Fundus photo
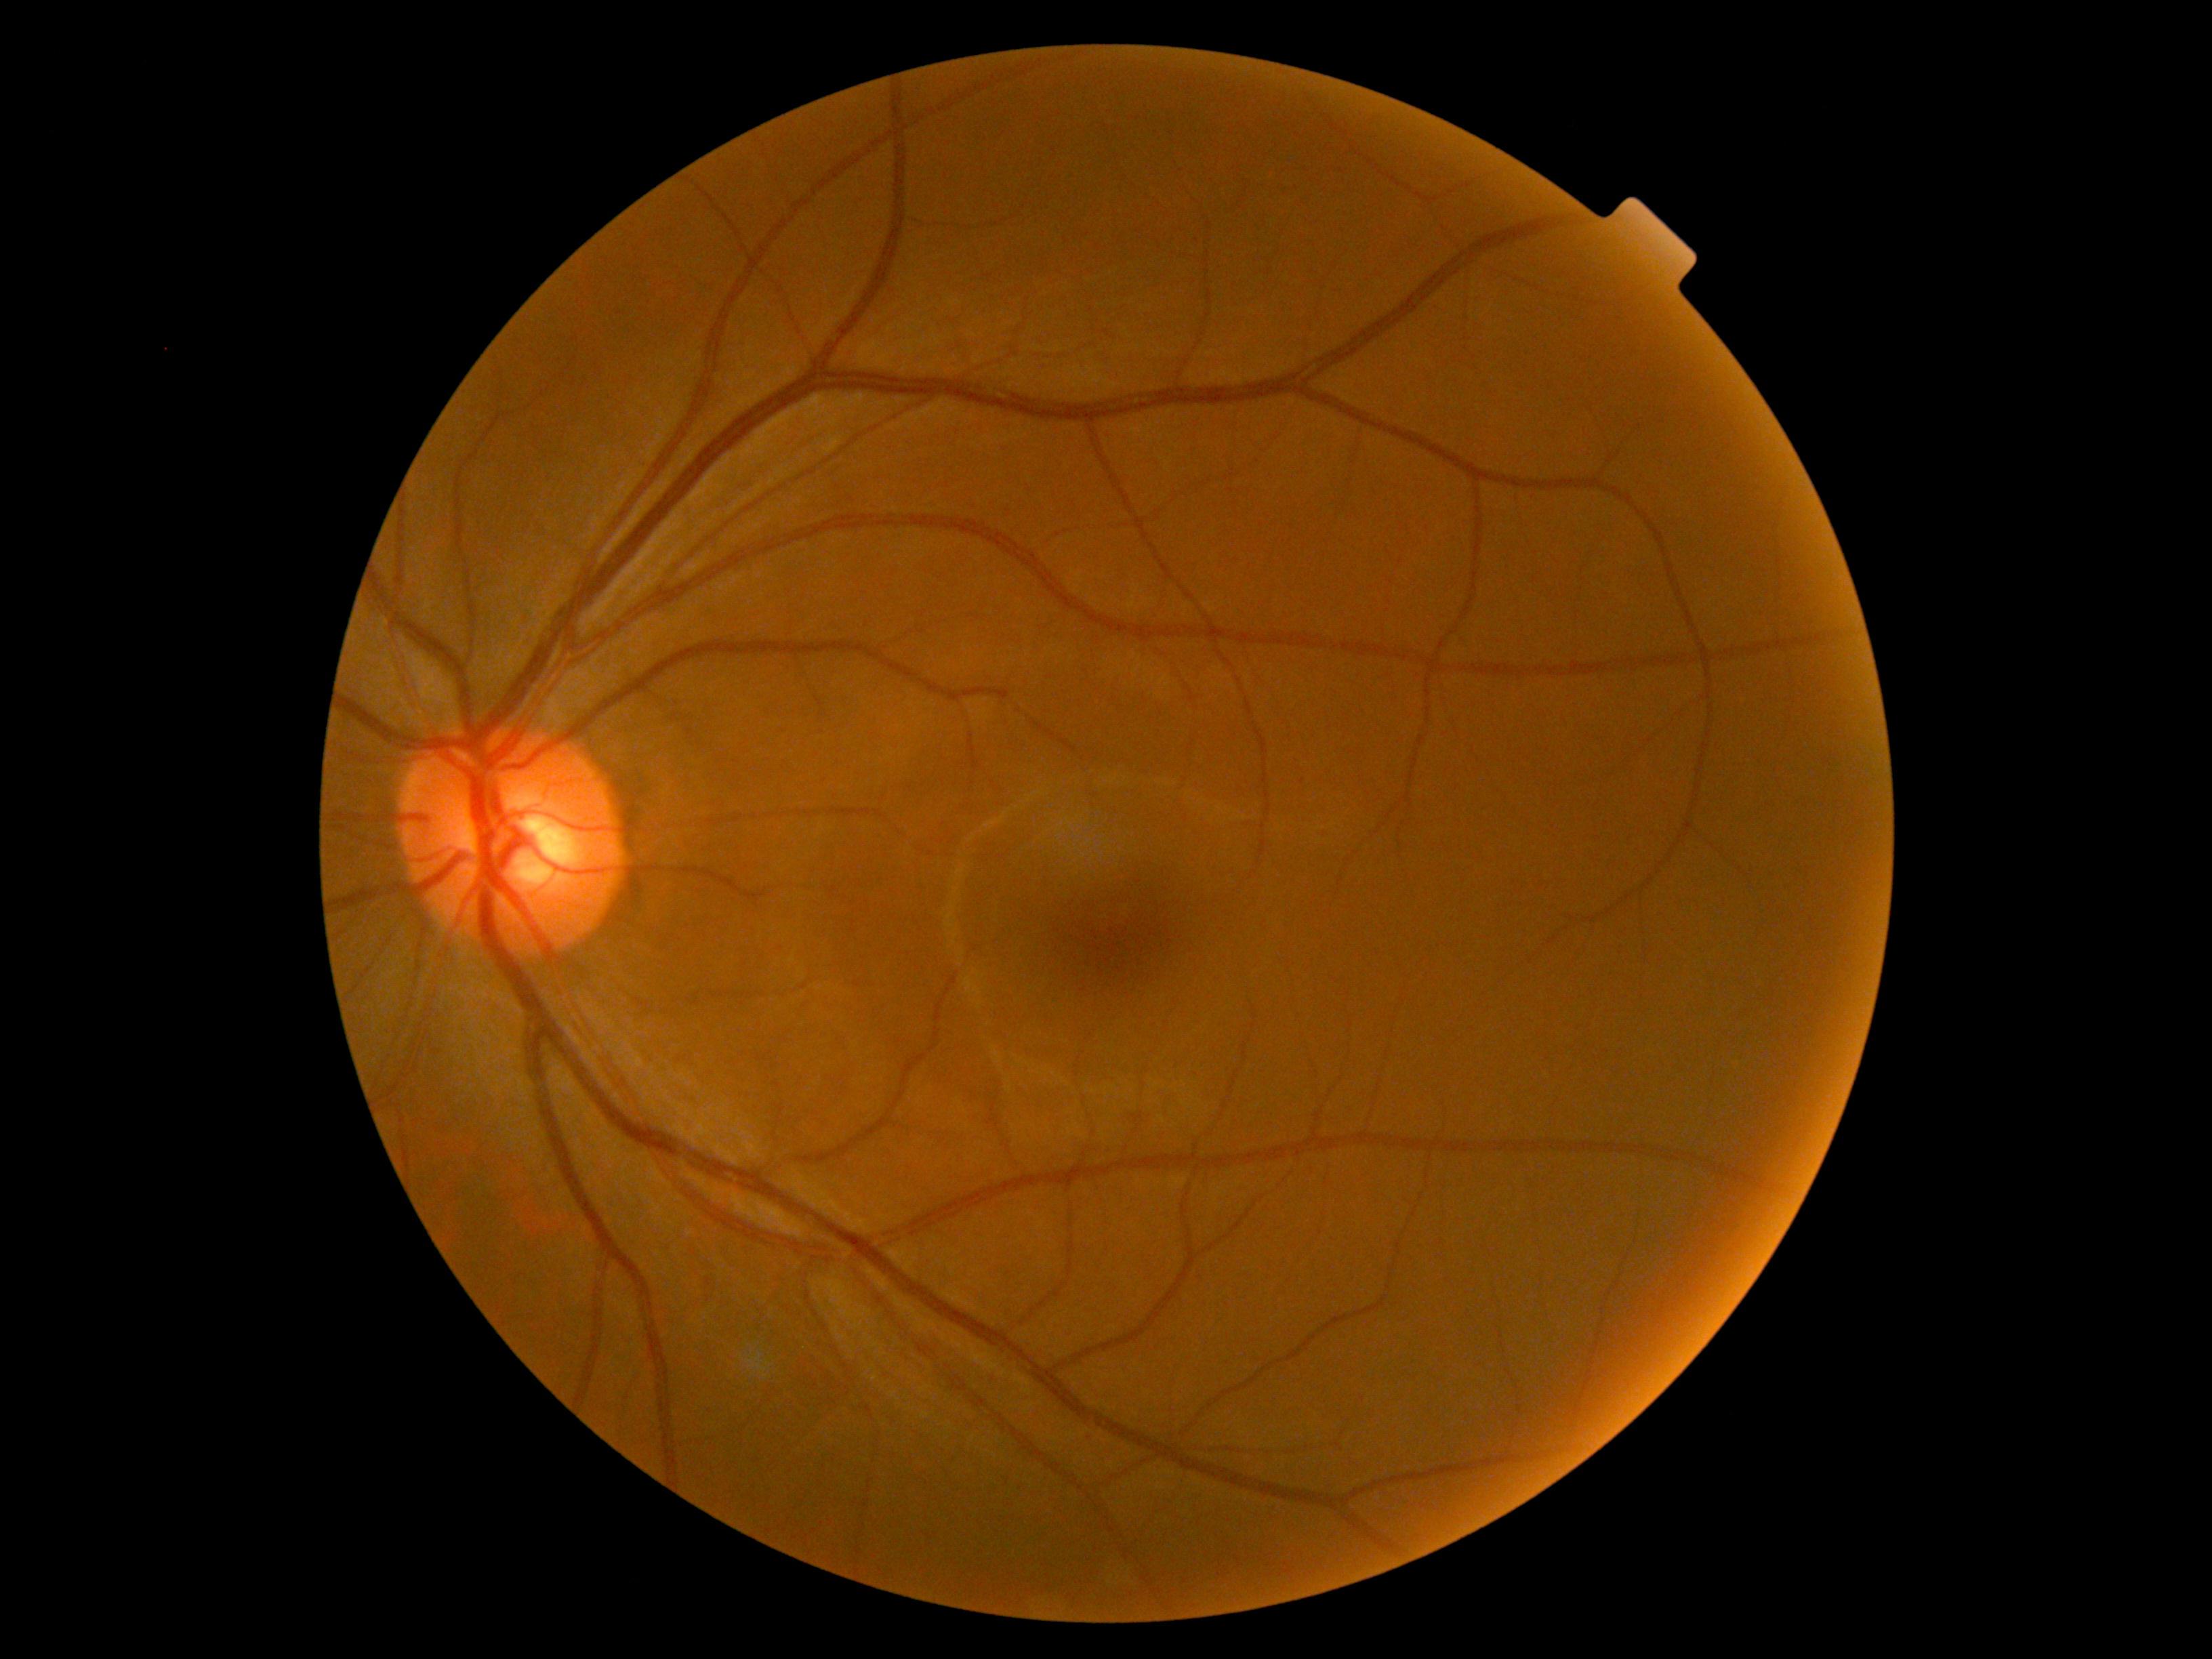

diabetic retinopathy = no apparent diabetic retinopathy (grade 0) — no visible signs of diabetic retinopathy, DR impression = no apparent DR.